Nonmydriatic fundus photograph. Graded on the modified Davis scale. 45-degree field of view.
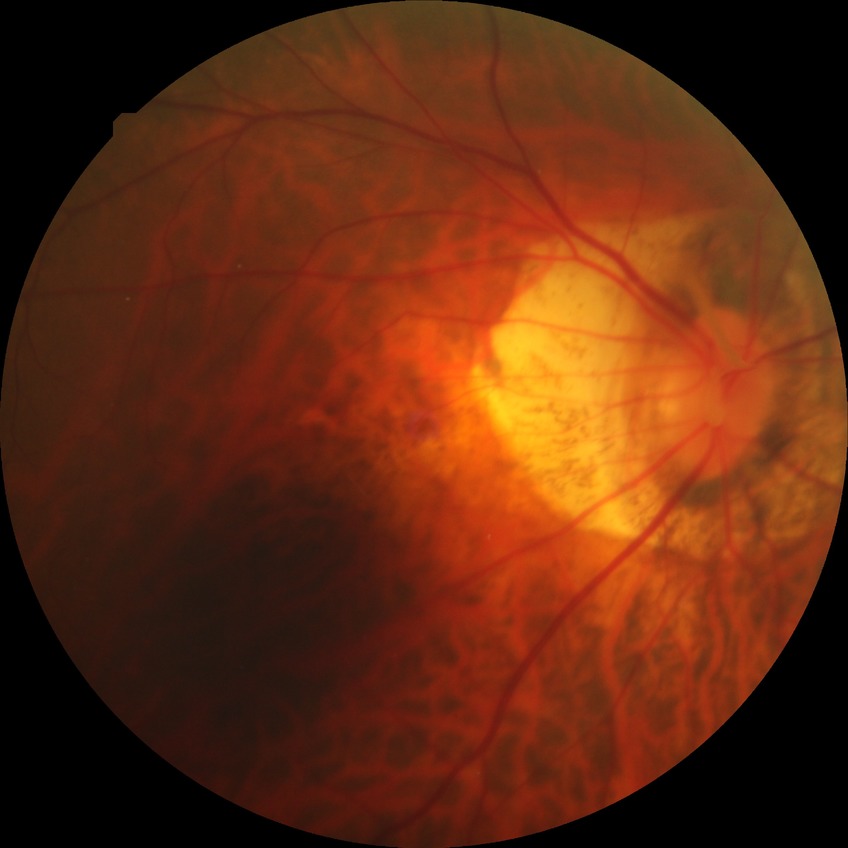
Modified Davis grading: no diabetic retinopathy.